Retinal fundus photograph, modified Davis grading: 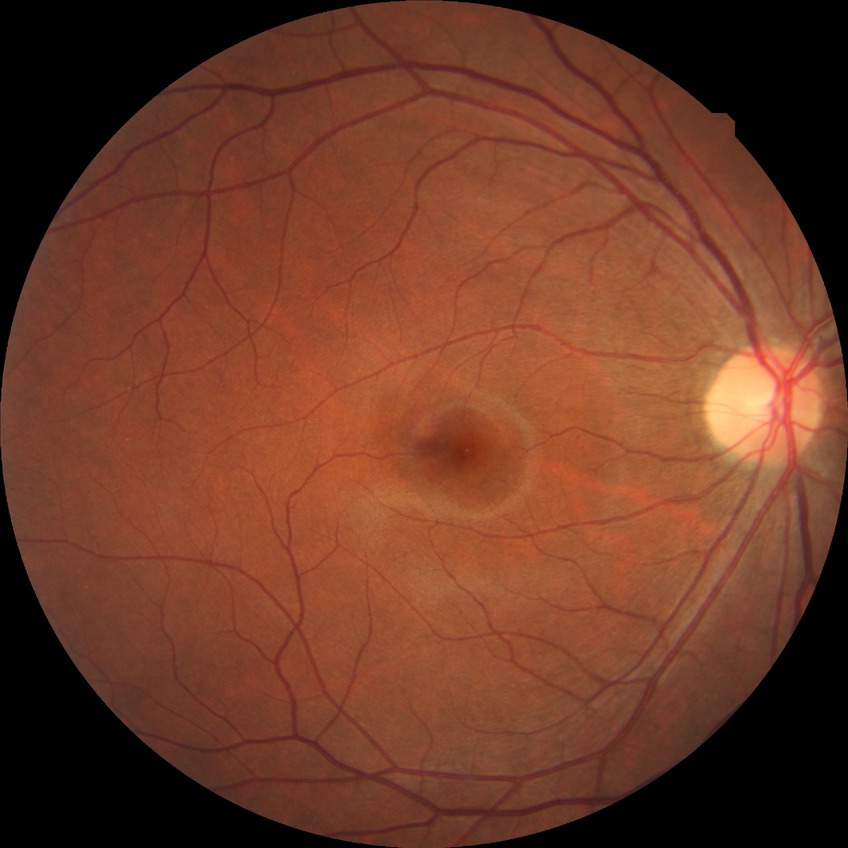 diabetic retinopathy (DR): no diabetic retinopathy (NDR).